Wide-field fundus photograph from neonatal ROP screening
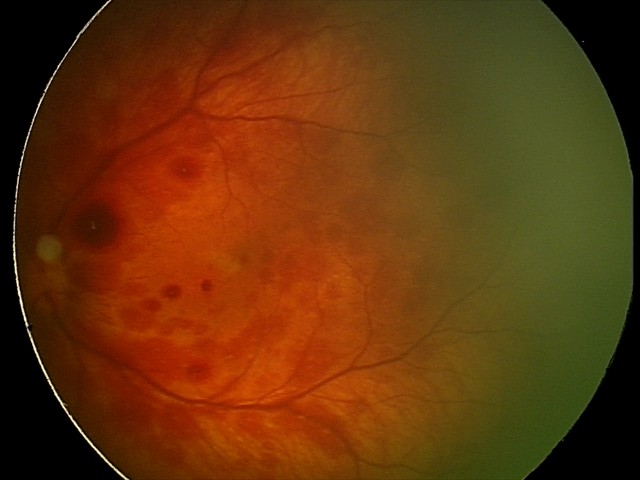
Impression: retinal hemorrhages.